CFP. 1960x1897px. 45-degree field of view: 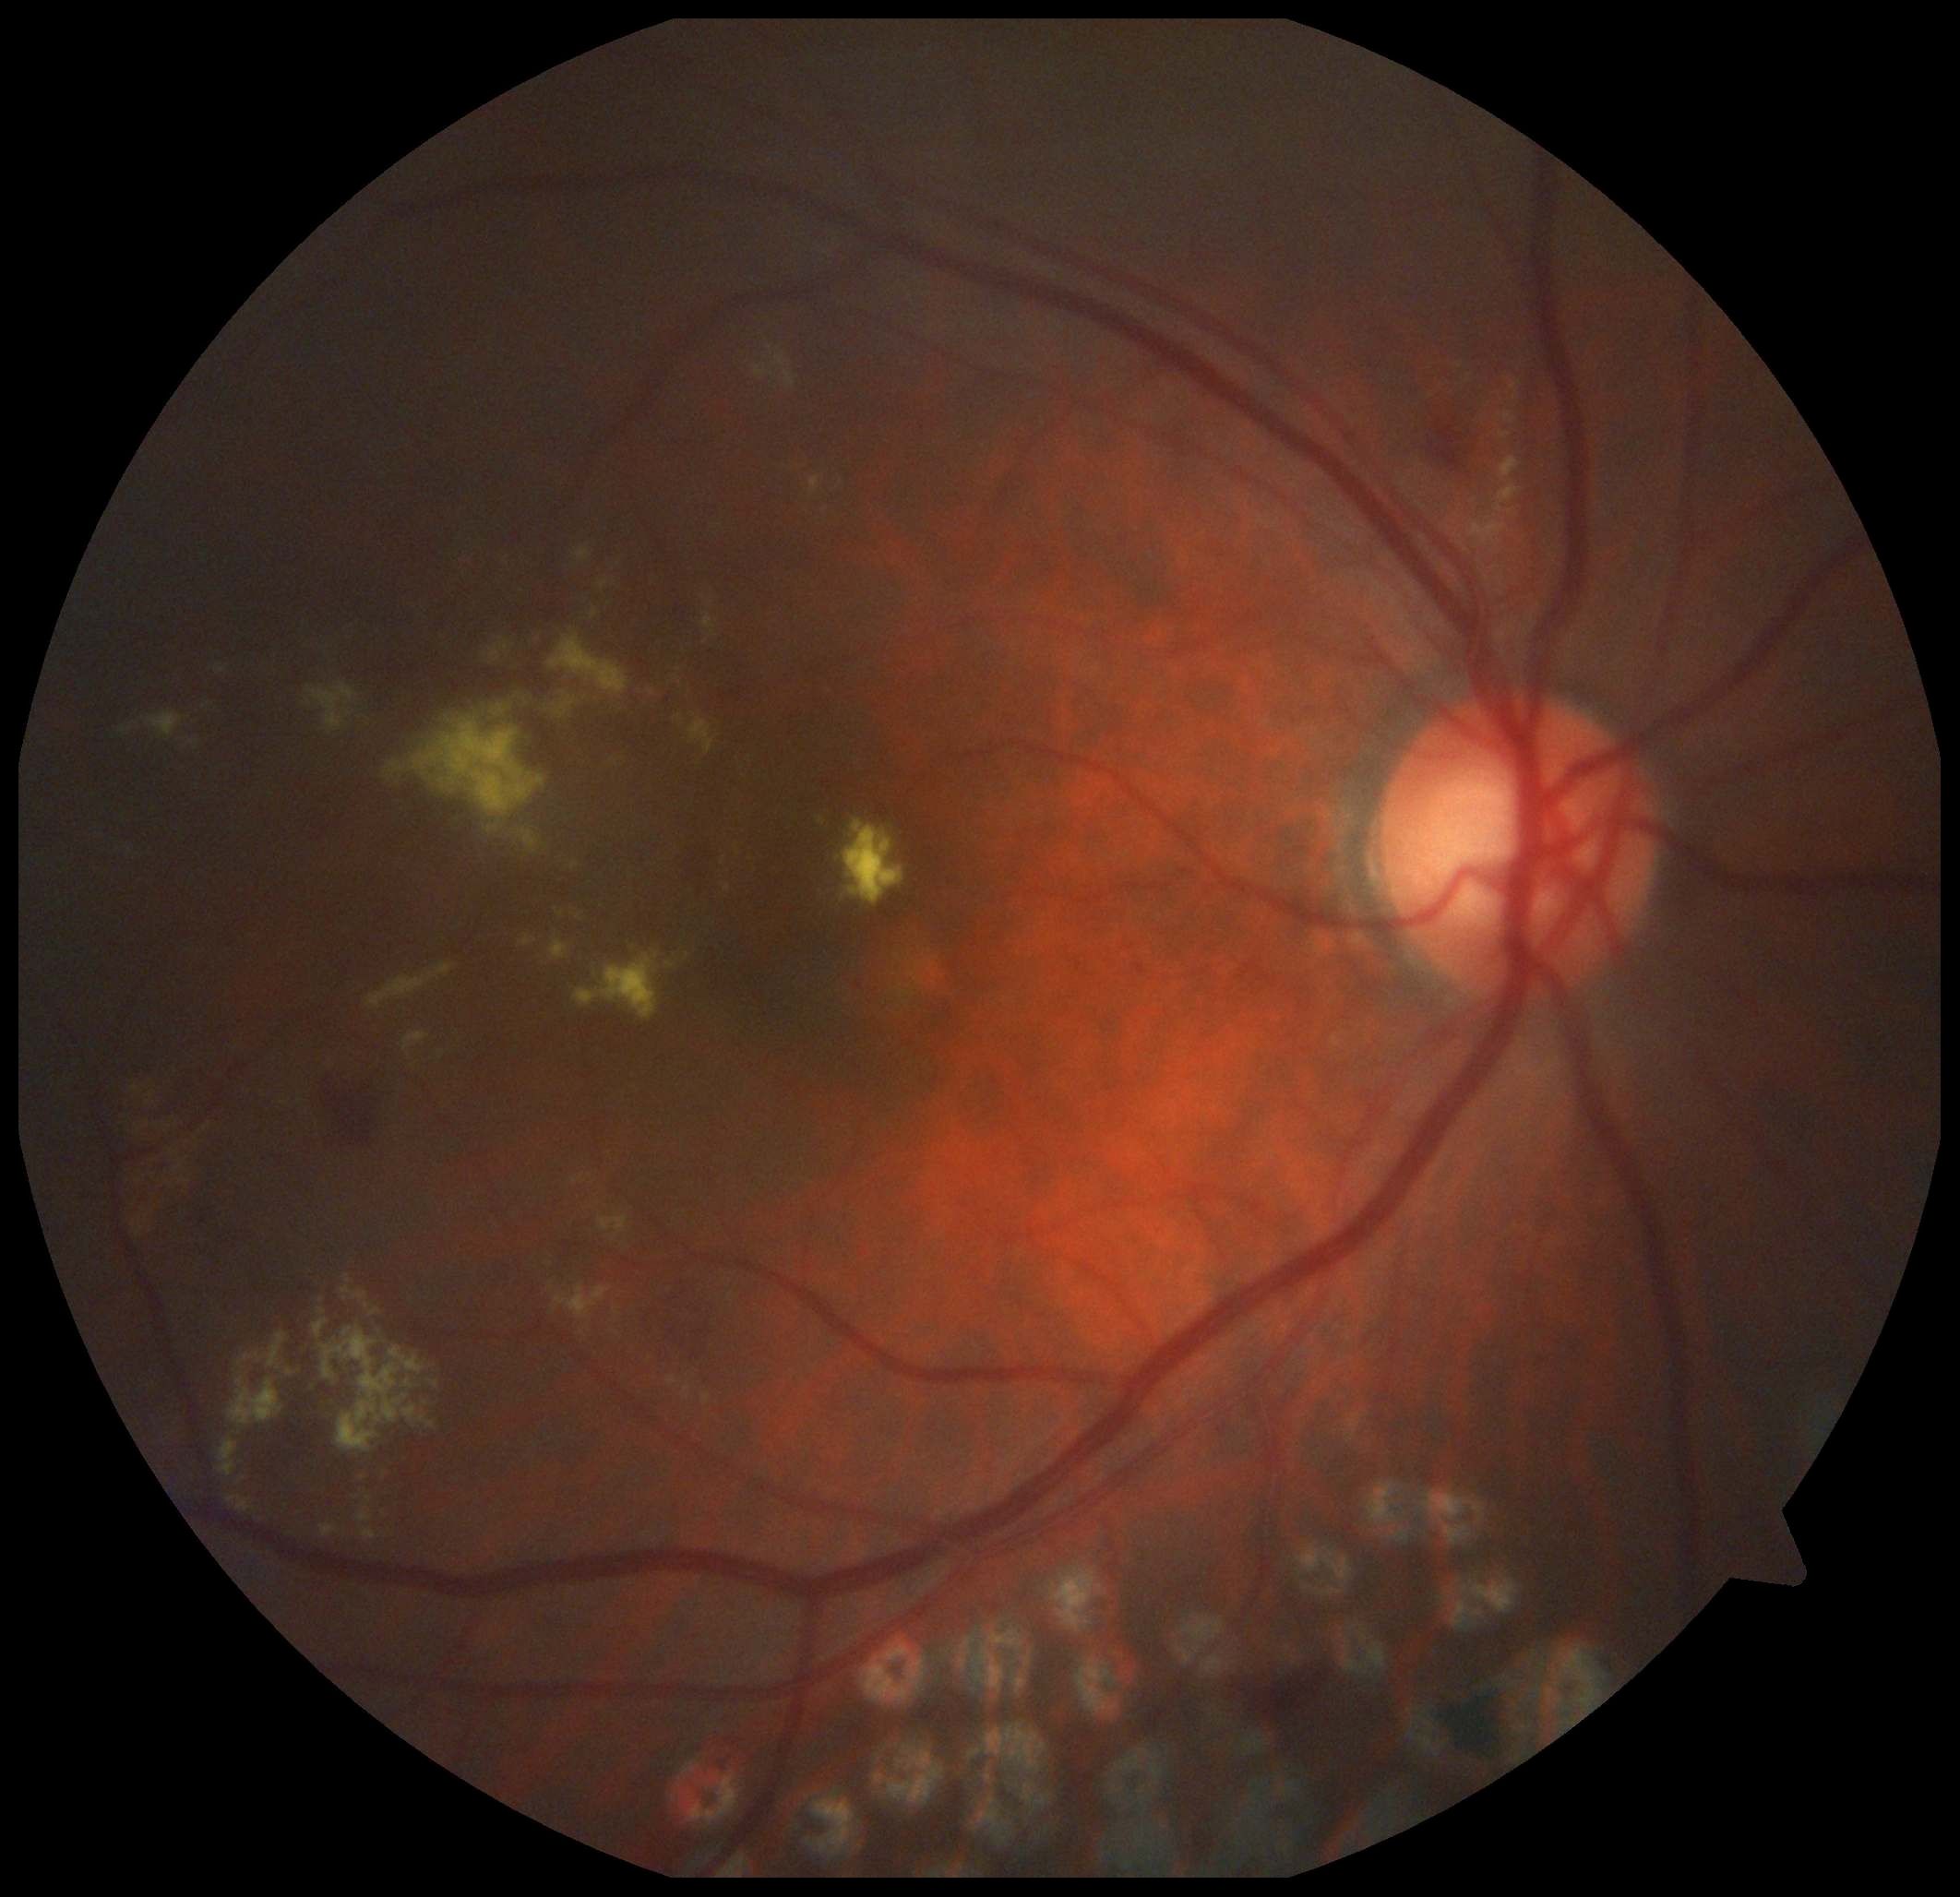
Annotations:
– diabetic retinopathy severity — 2